Fundus photo · 45-degree field of view · 2352 x 1568 pixels — 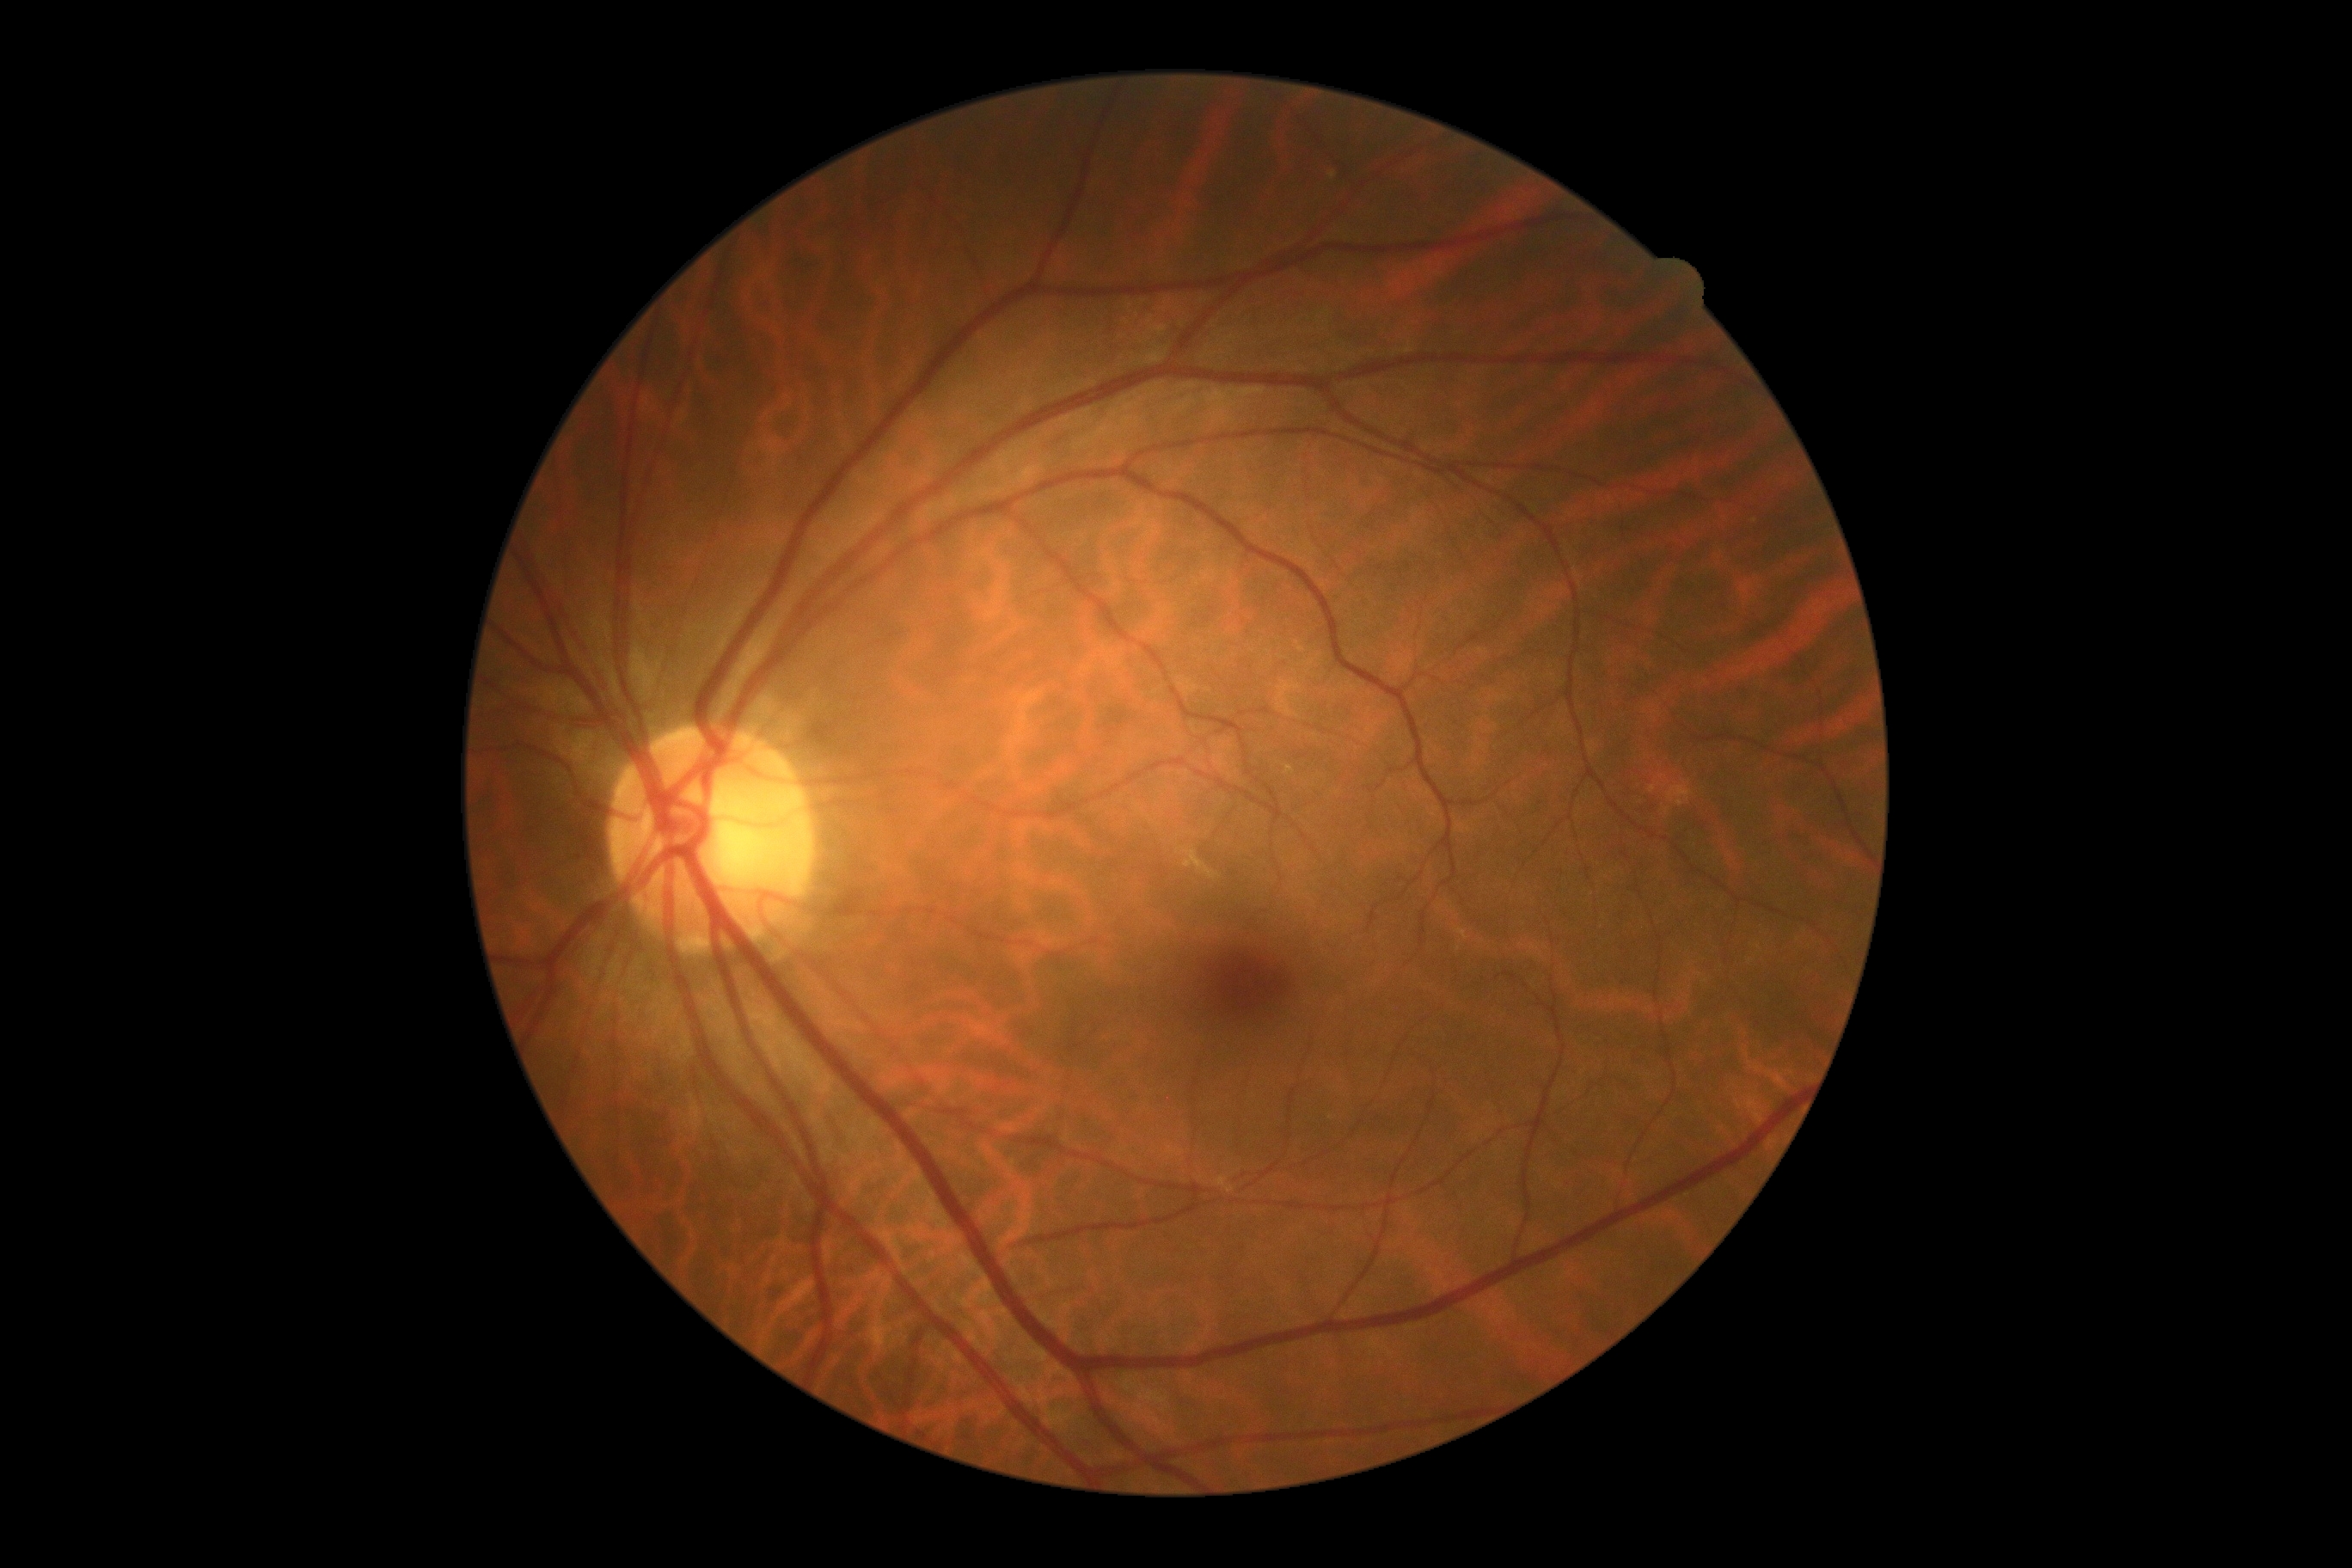 retinopathy grade = 0 (no apparent retinopathy) — no visible signs of diabetic retinopathy
DR impression = negative for DR